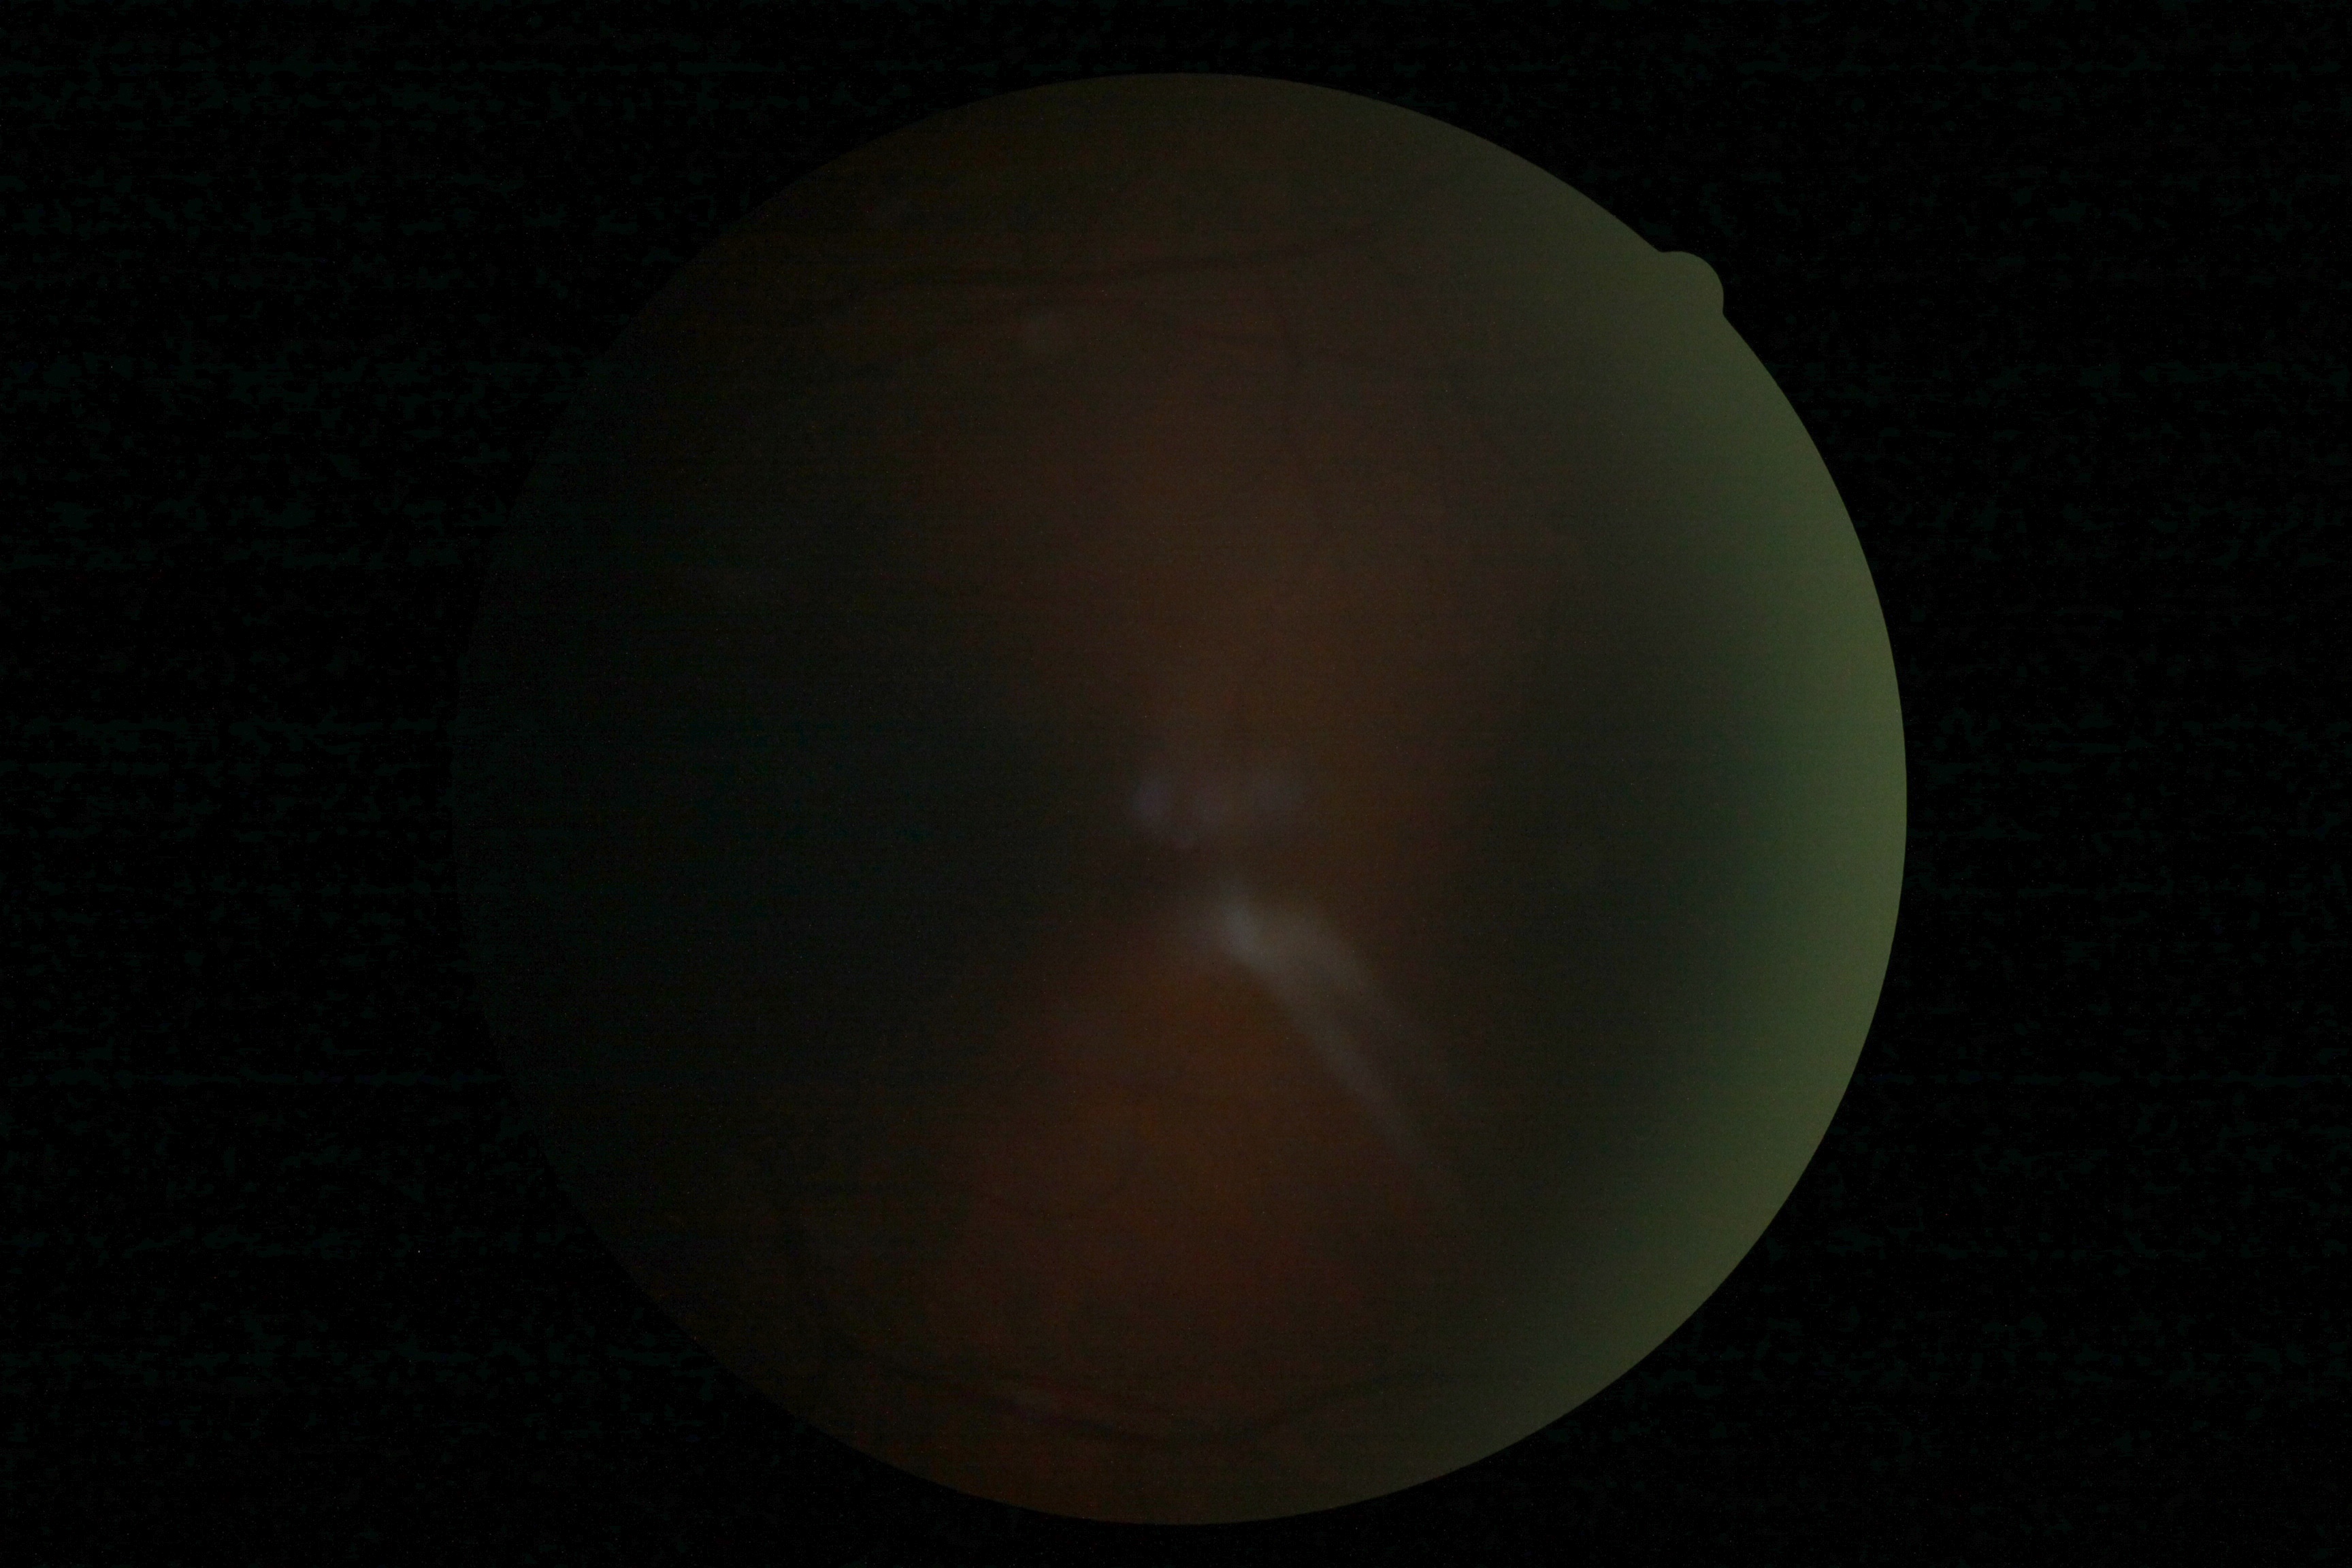
The image cannot be graded for diabetic retinopathy. Diabetic retinopathy grade: ungradable due to poor image quality.